Color fundus photograph · camera: NIDEK AFC-230 · without pupil dilation · FOV: 45 degrees · image size 848x848 — 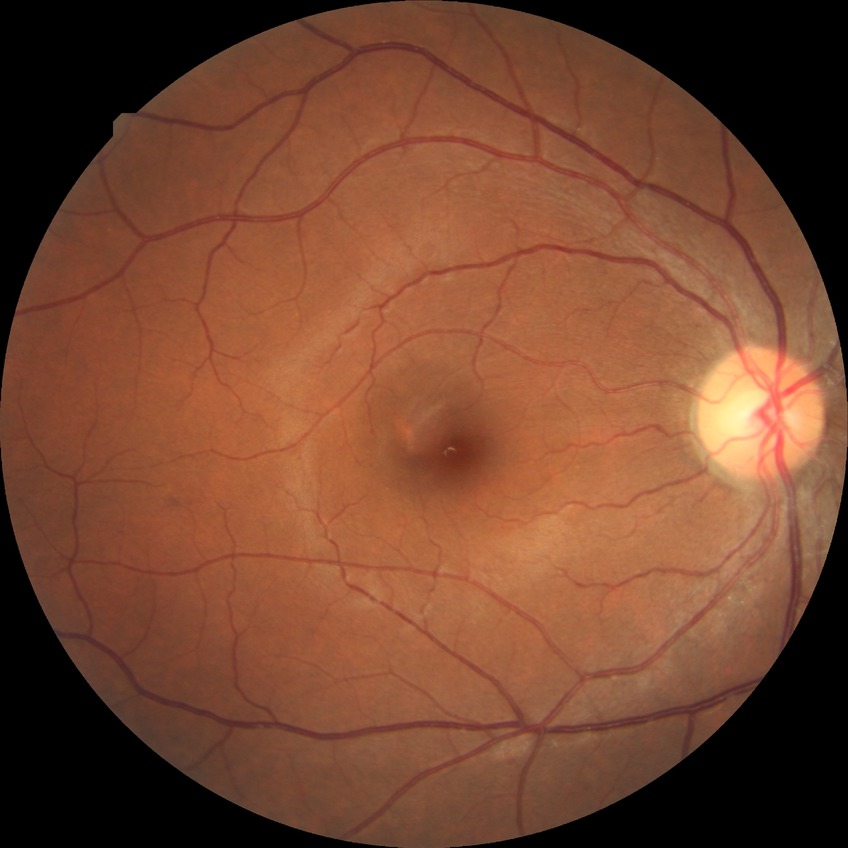 Diabetic retinopathy stage: no diabetic retinopathy.